Wide-field contact fundus photograph of an infant.
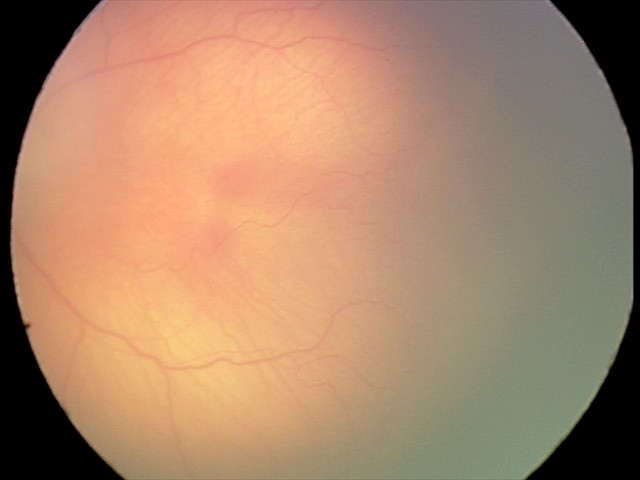
Screening series with ROP stage 1.
Plus disease absent.